NIDEK AFC-230 fundus camera; no pharmacologic dilation; diabetic retinopathy graded by the modified Davis classification; image size 848x848
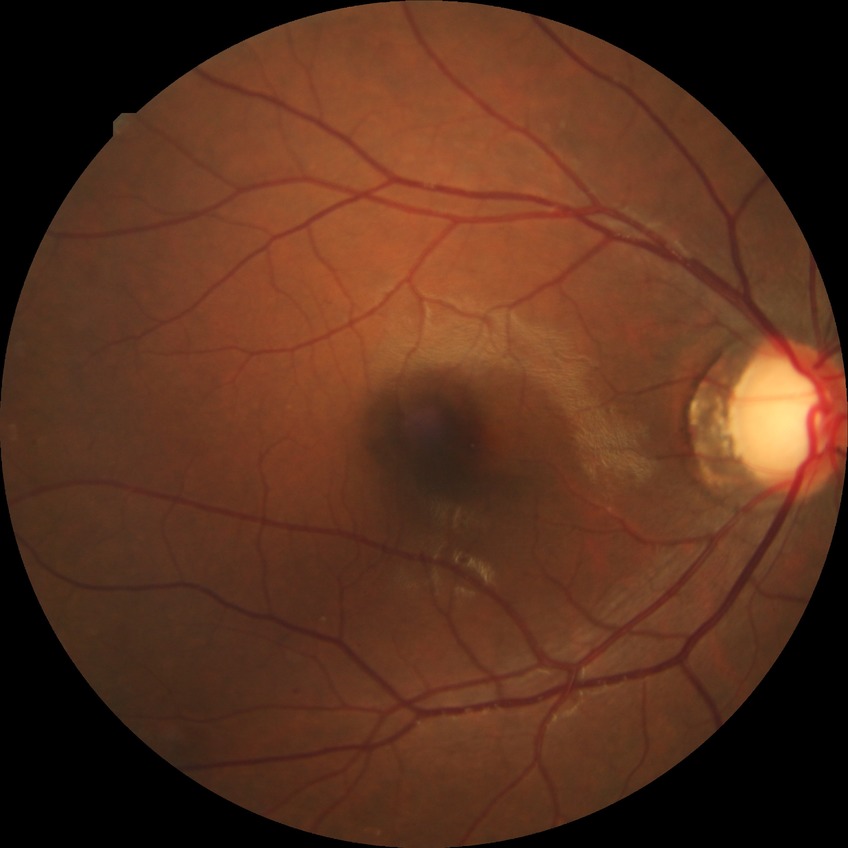
Diabetic retinopathy (DR): simple diabetic retinopathy (SDR).